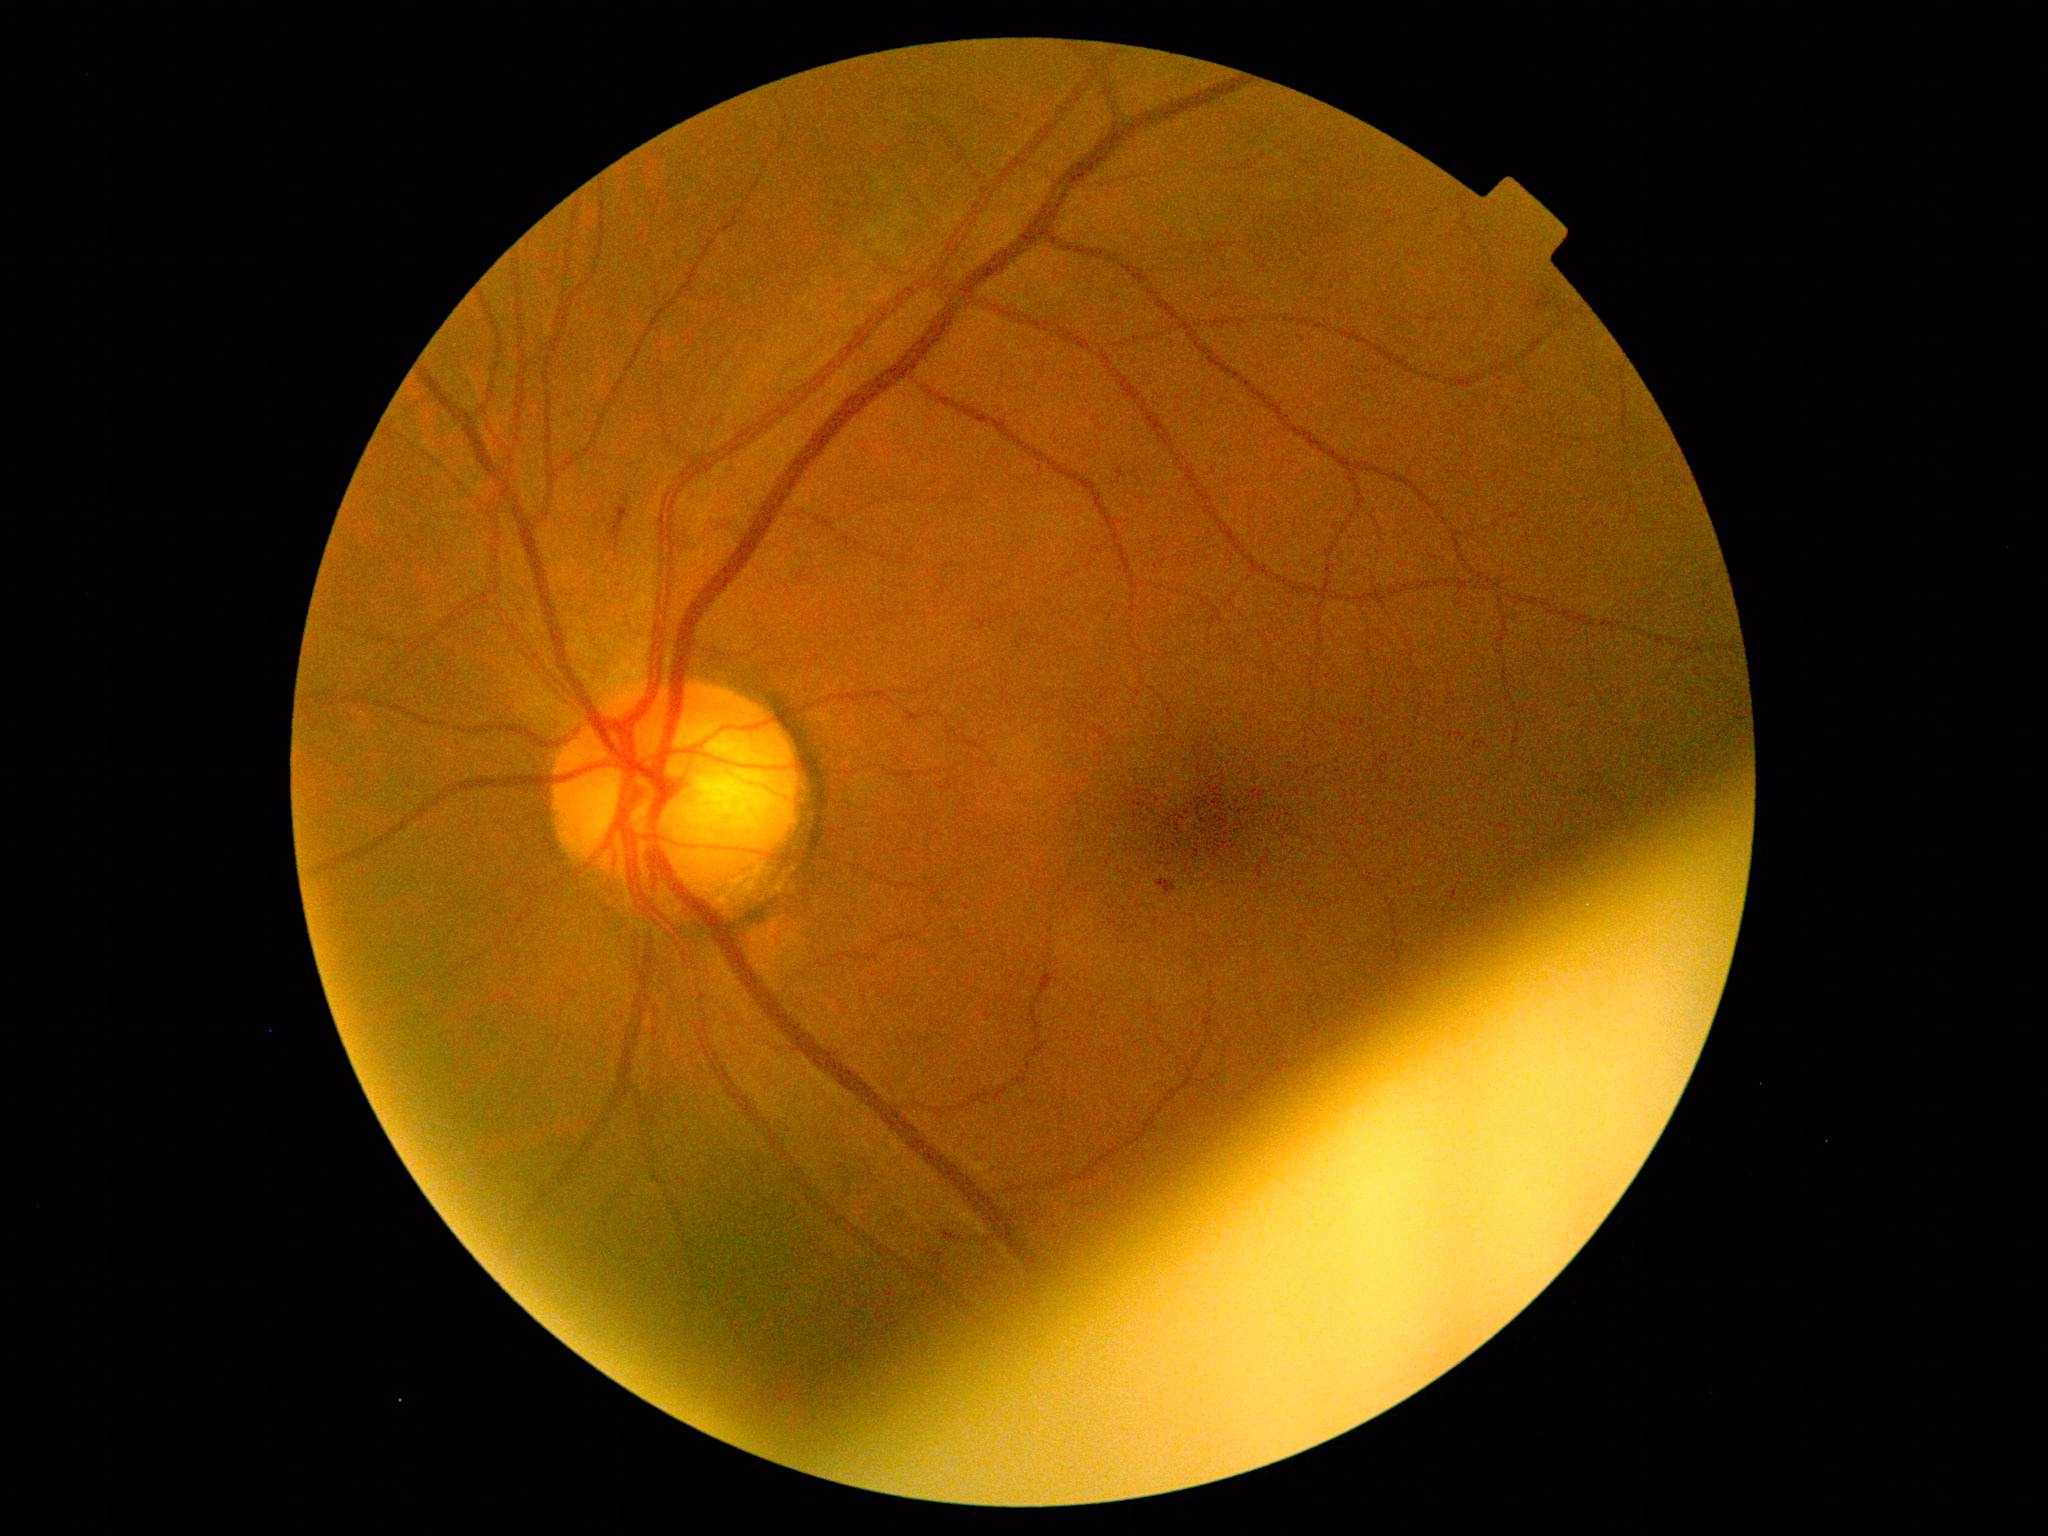 Diabetic retinopathy (DR) is 2.